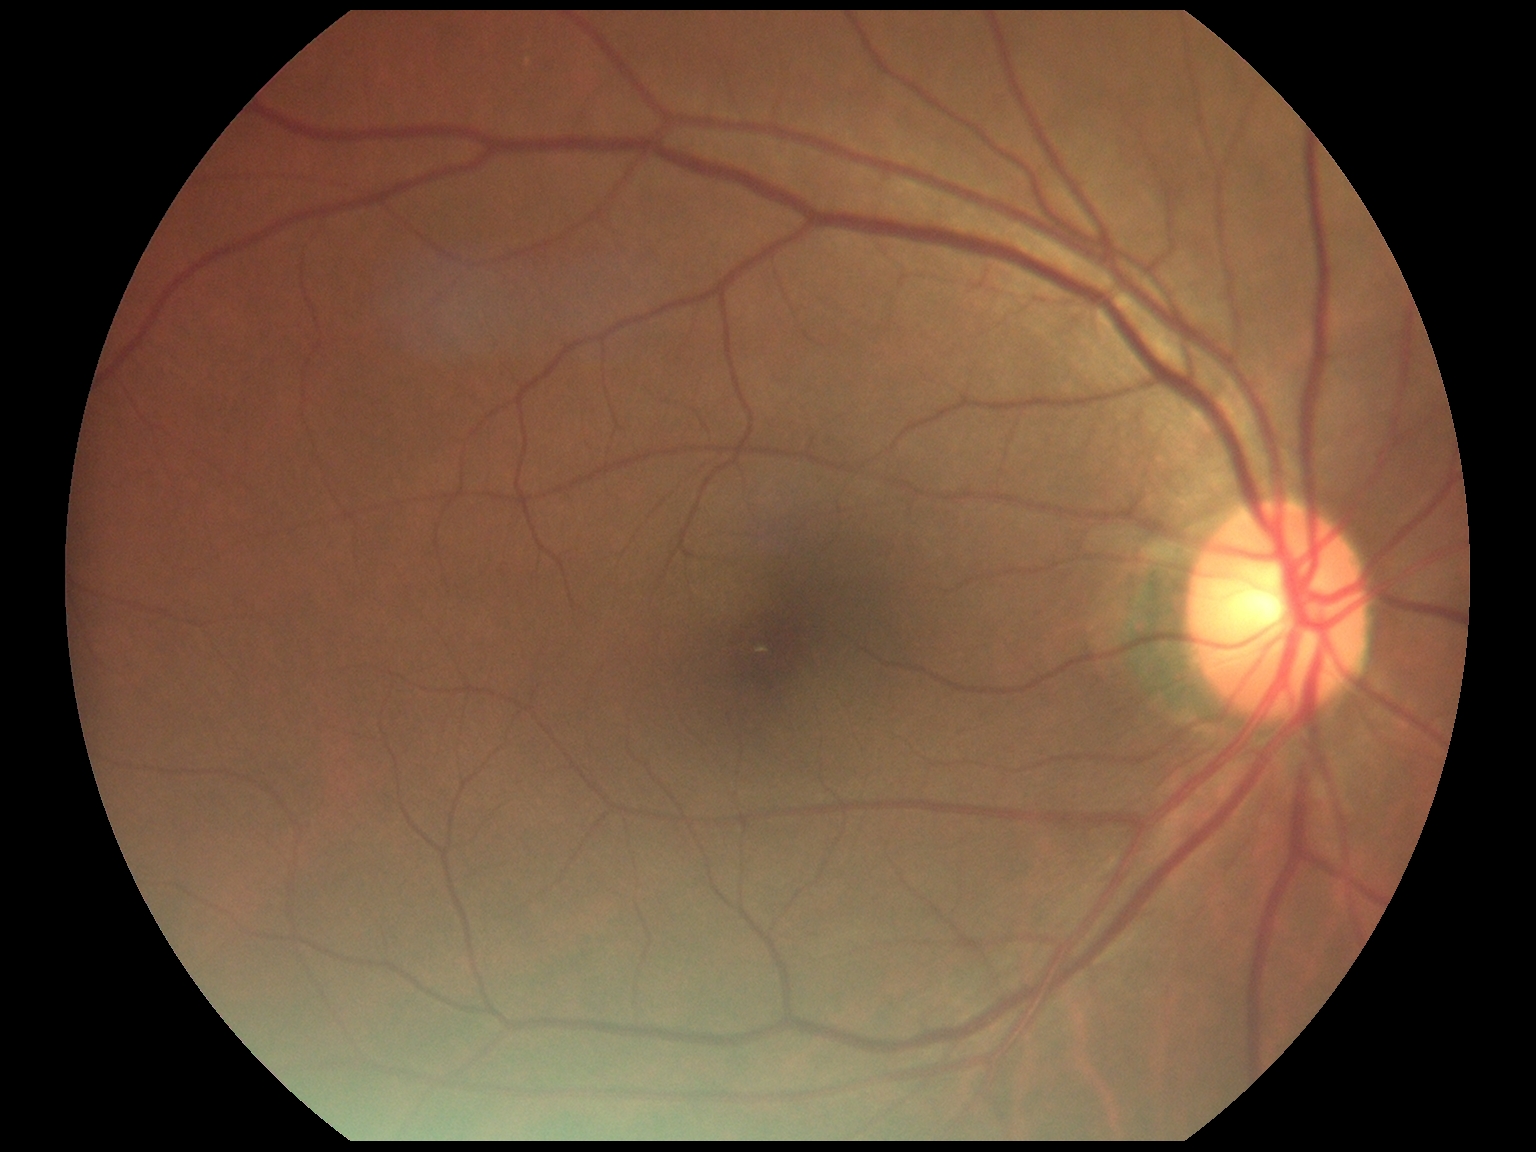

DR: grade 0 (no apparent retinopathy).